Without pupil dilation · modified Davis classification:
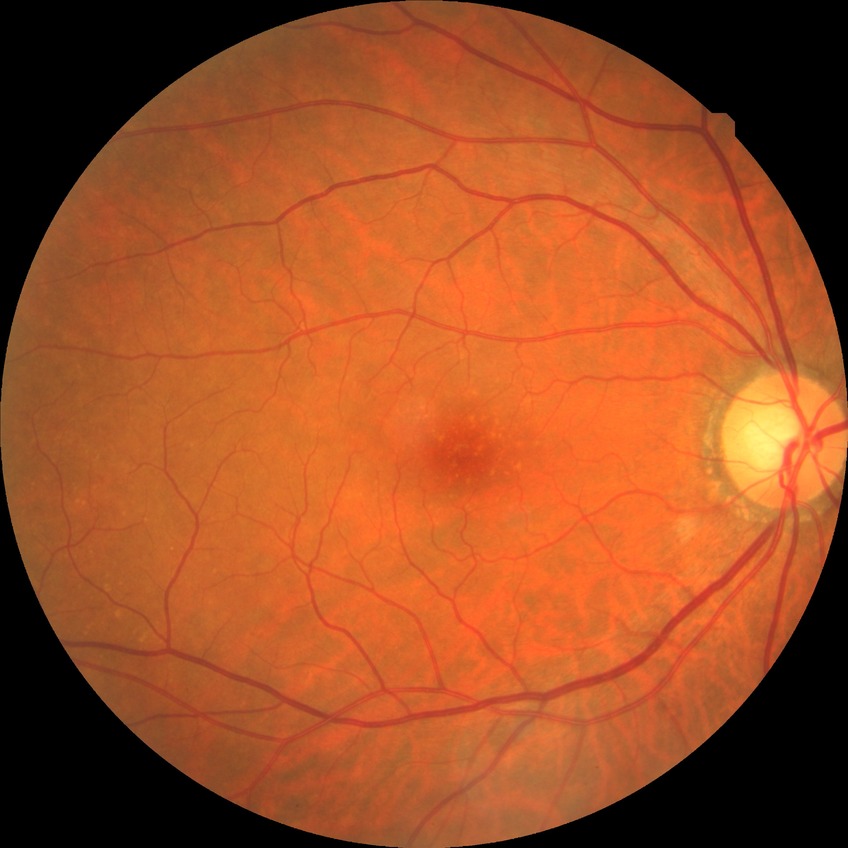
Davis grading: no diabetic retinopathy.